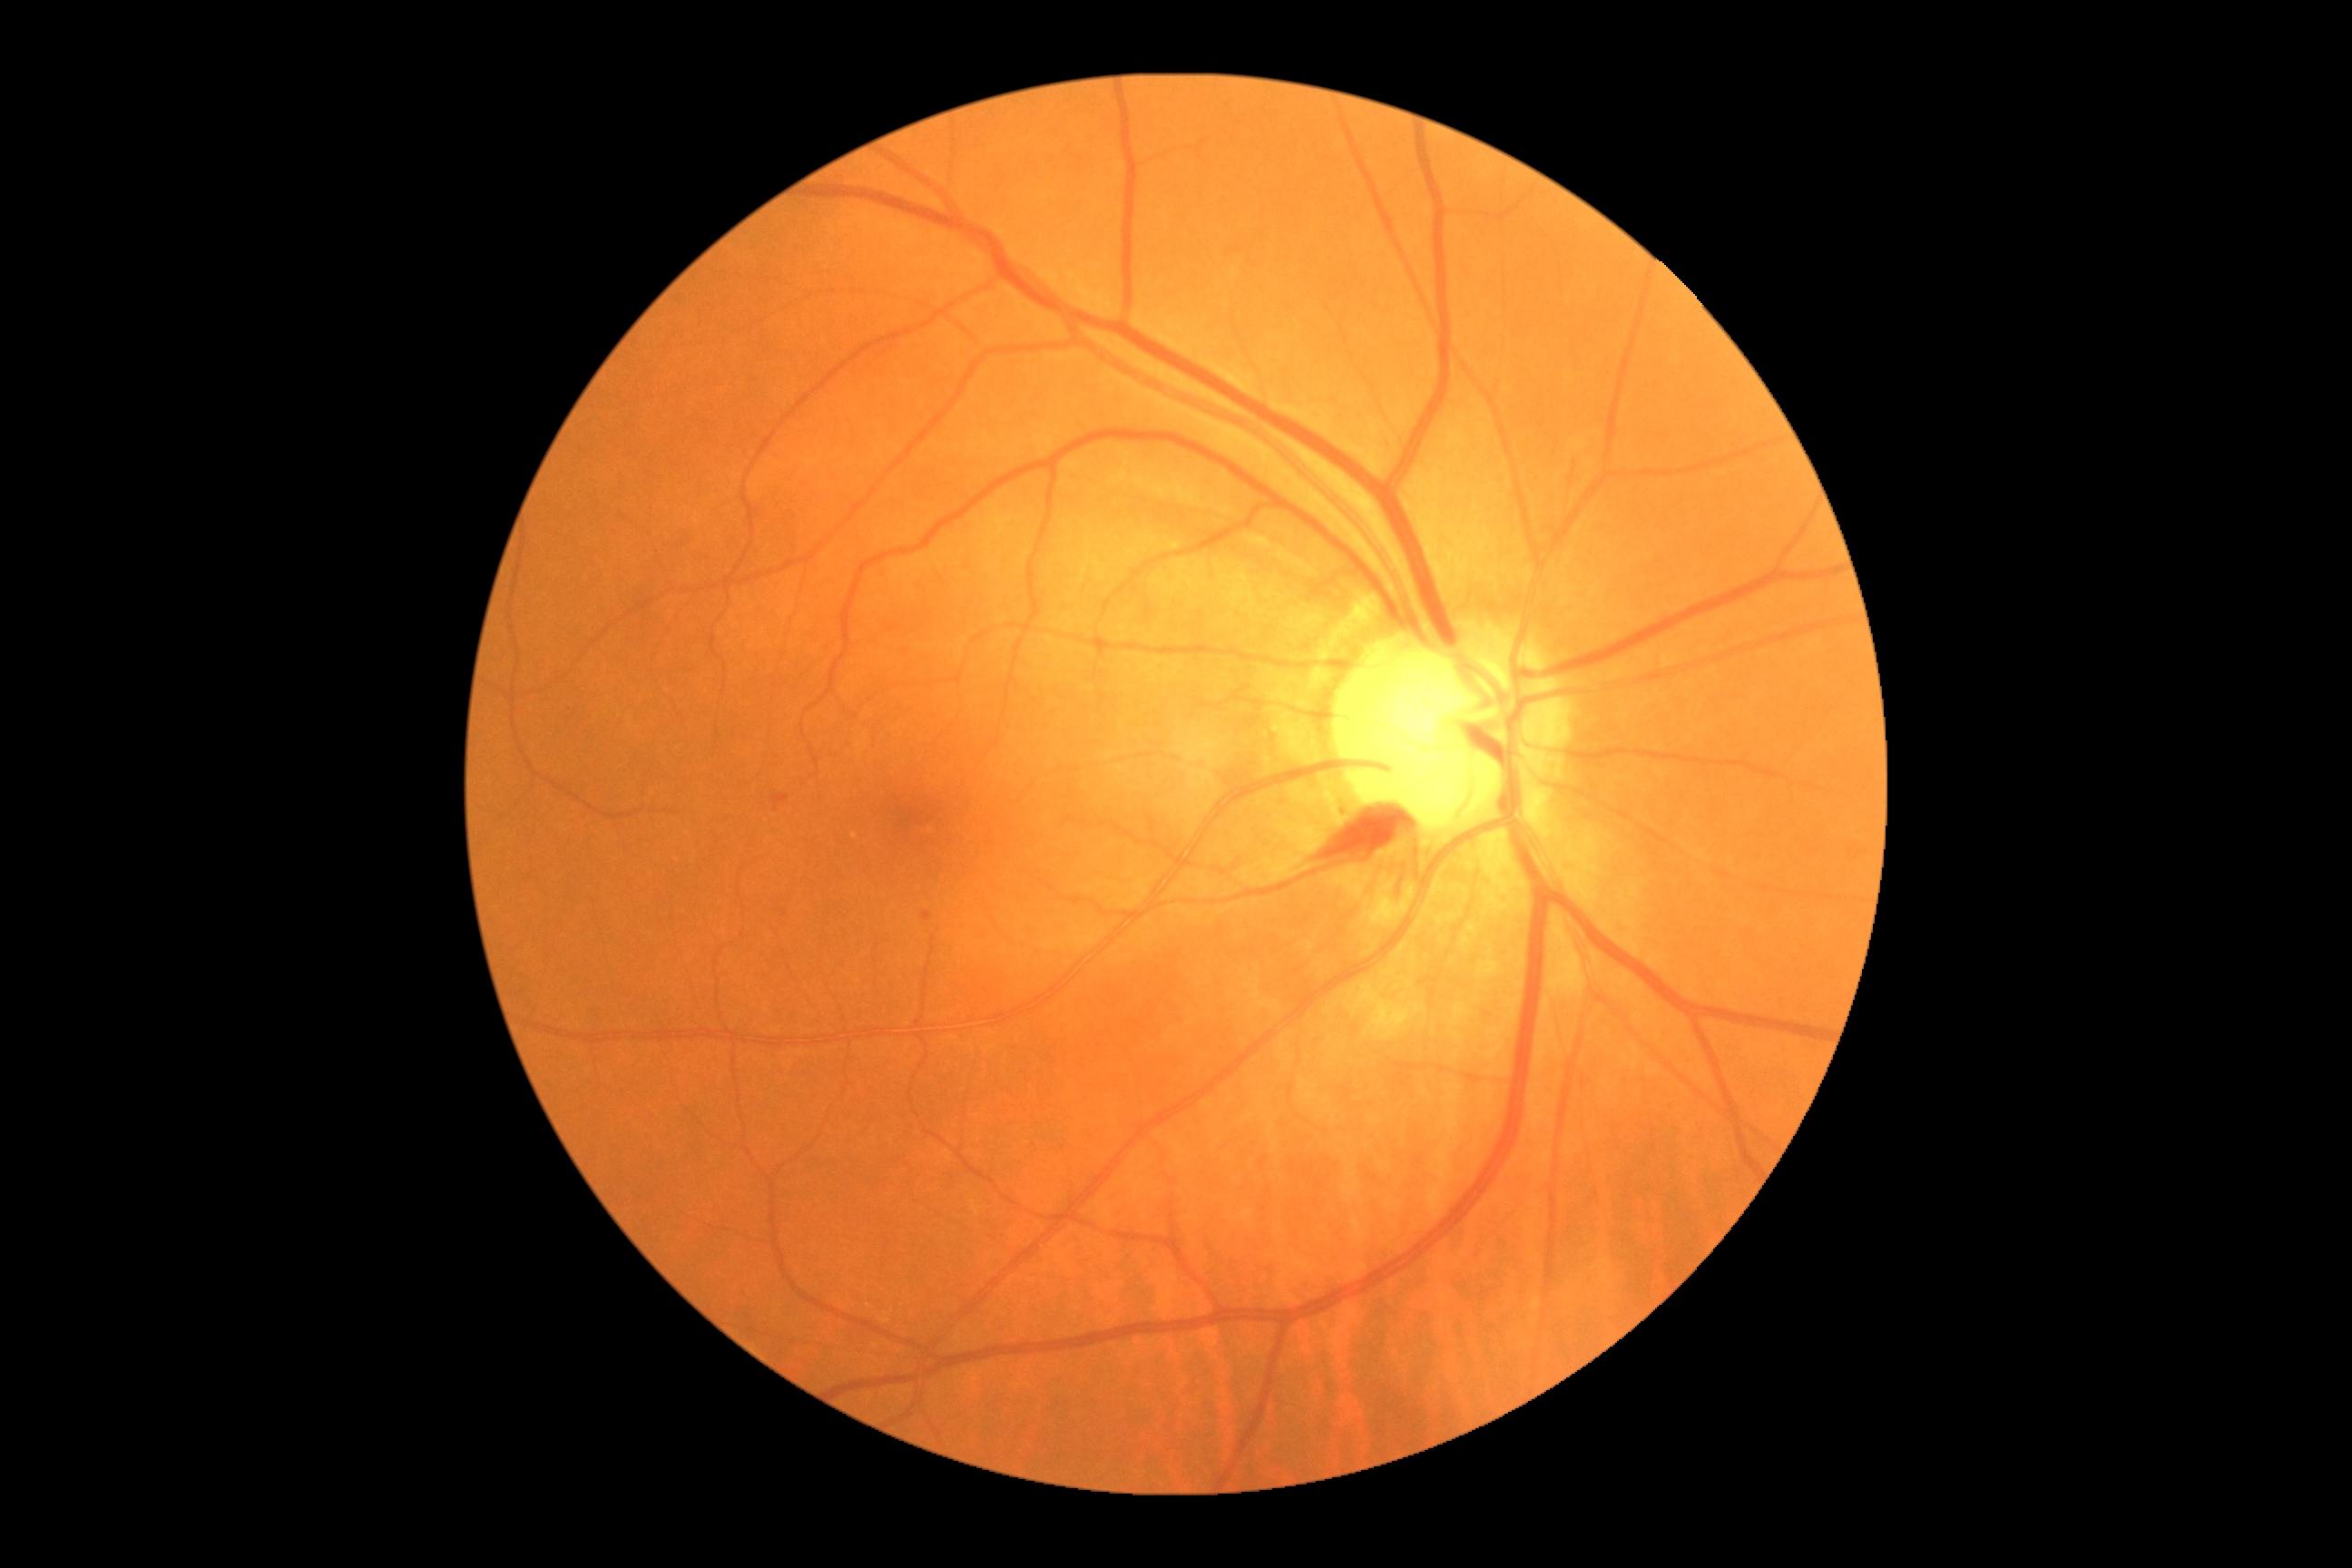 DR stage is grade 2 (moderate NPDR).